Camera: NIDEK AFC-230. Posterior pole photograph. No pharmacologic dilation. Modified Davis grading:
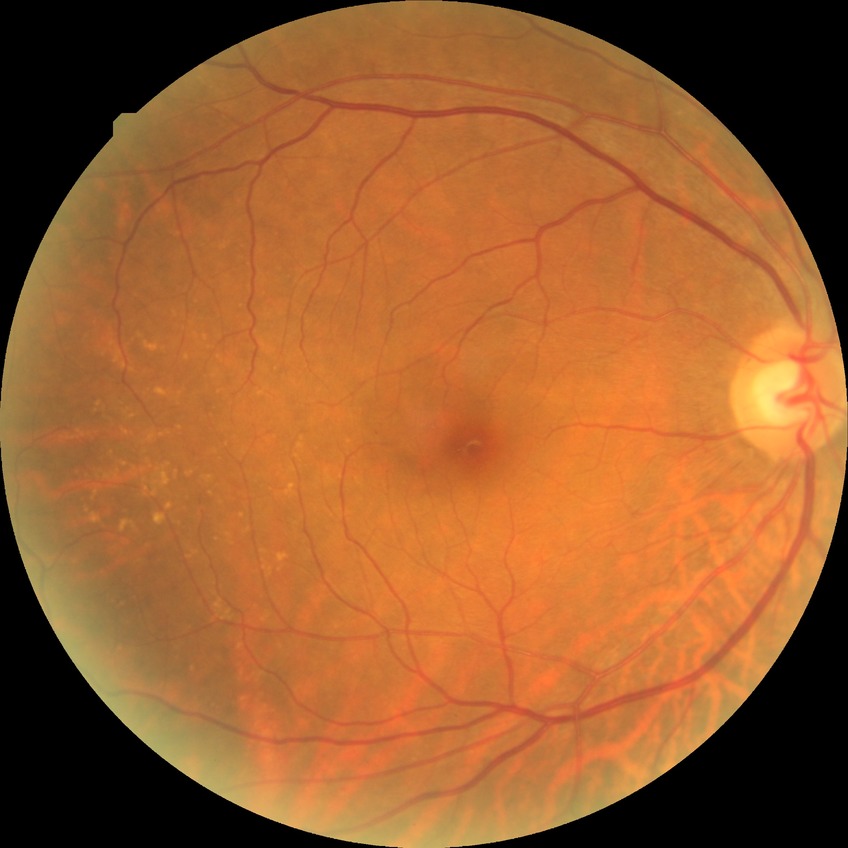

Davis grading: no diabetic retinopathy.